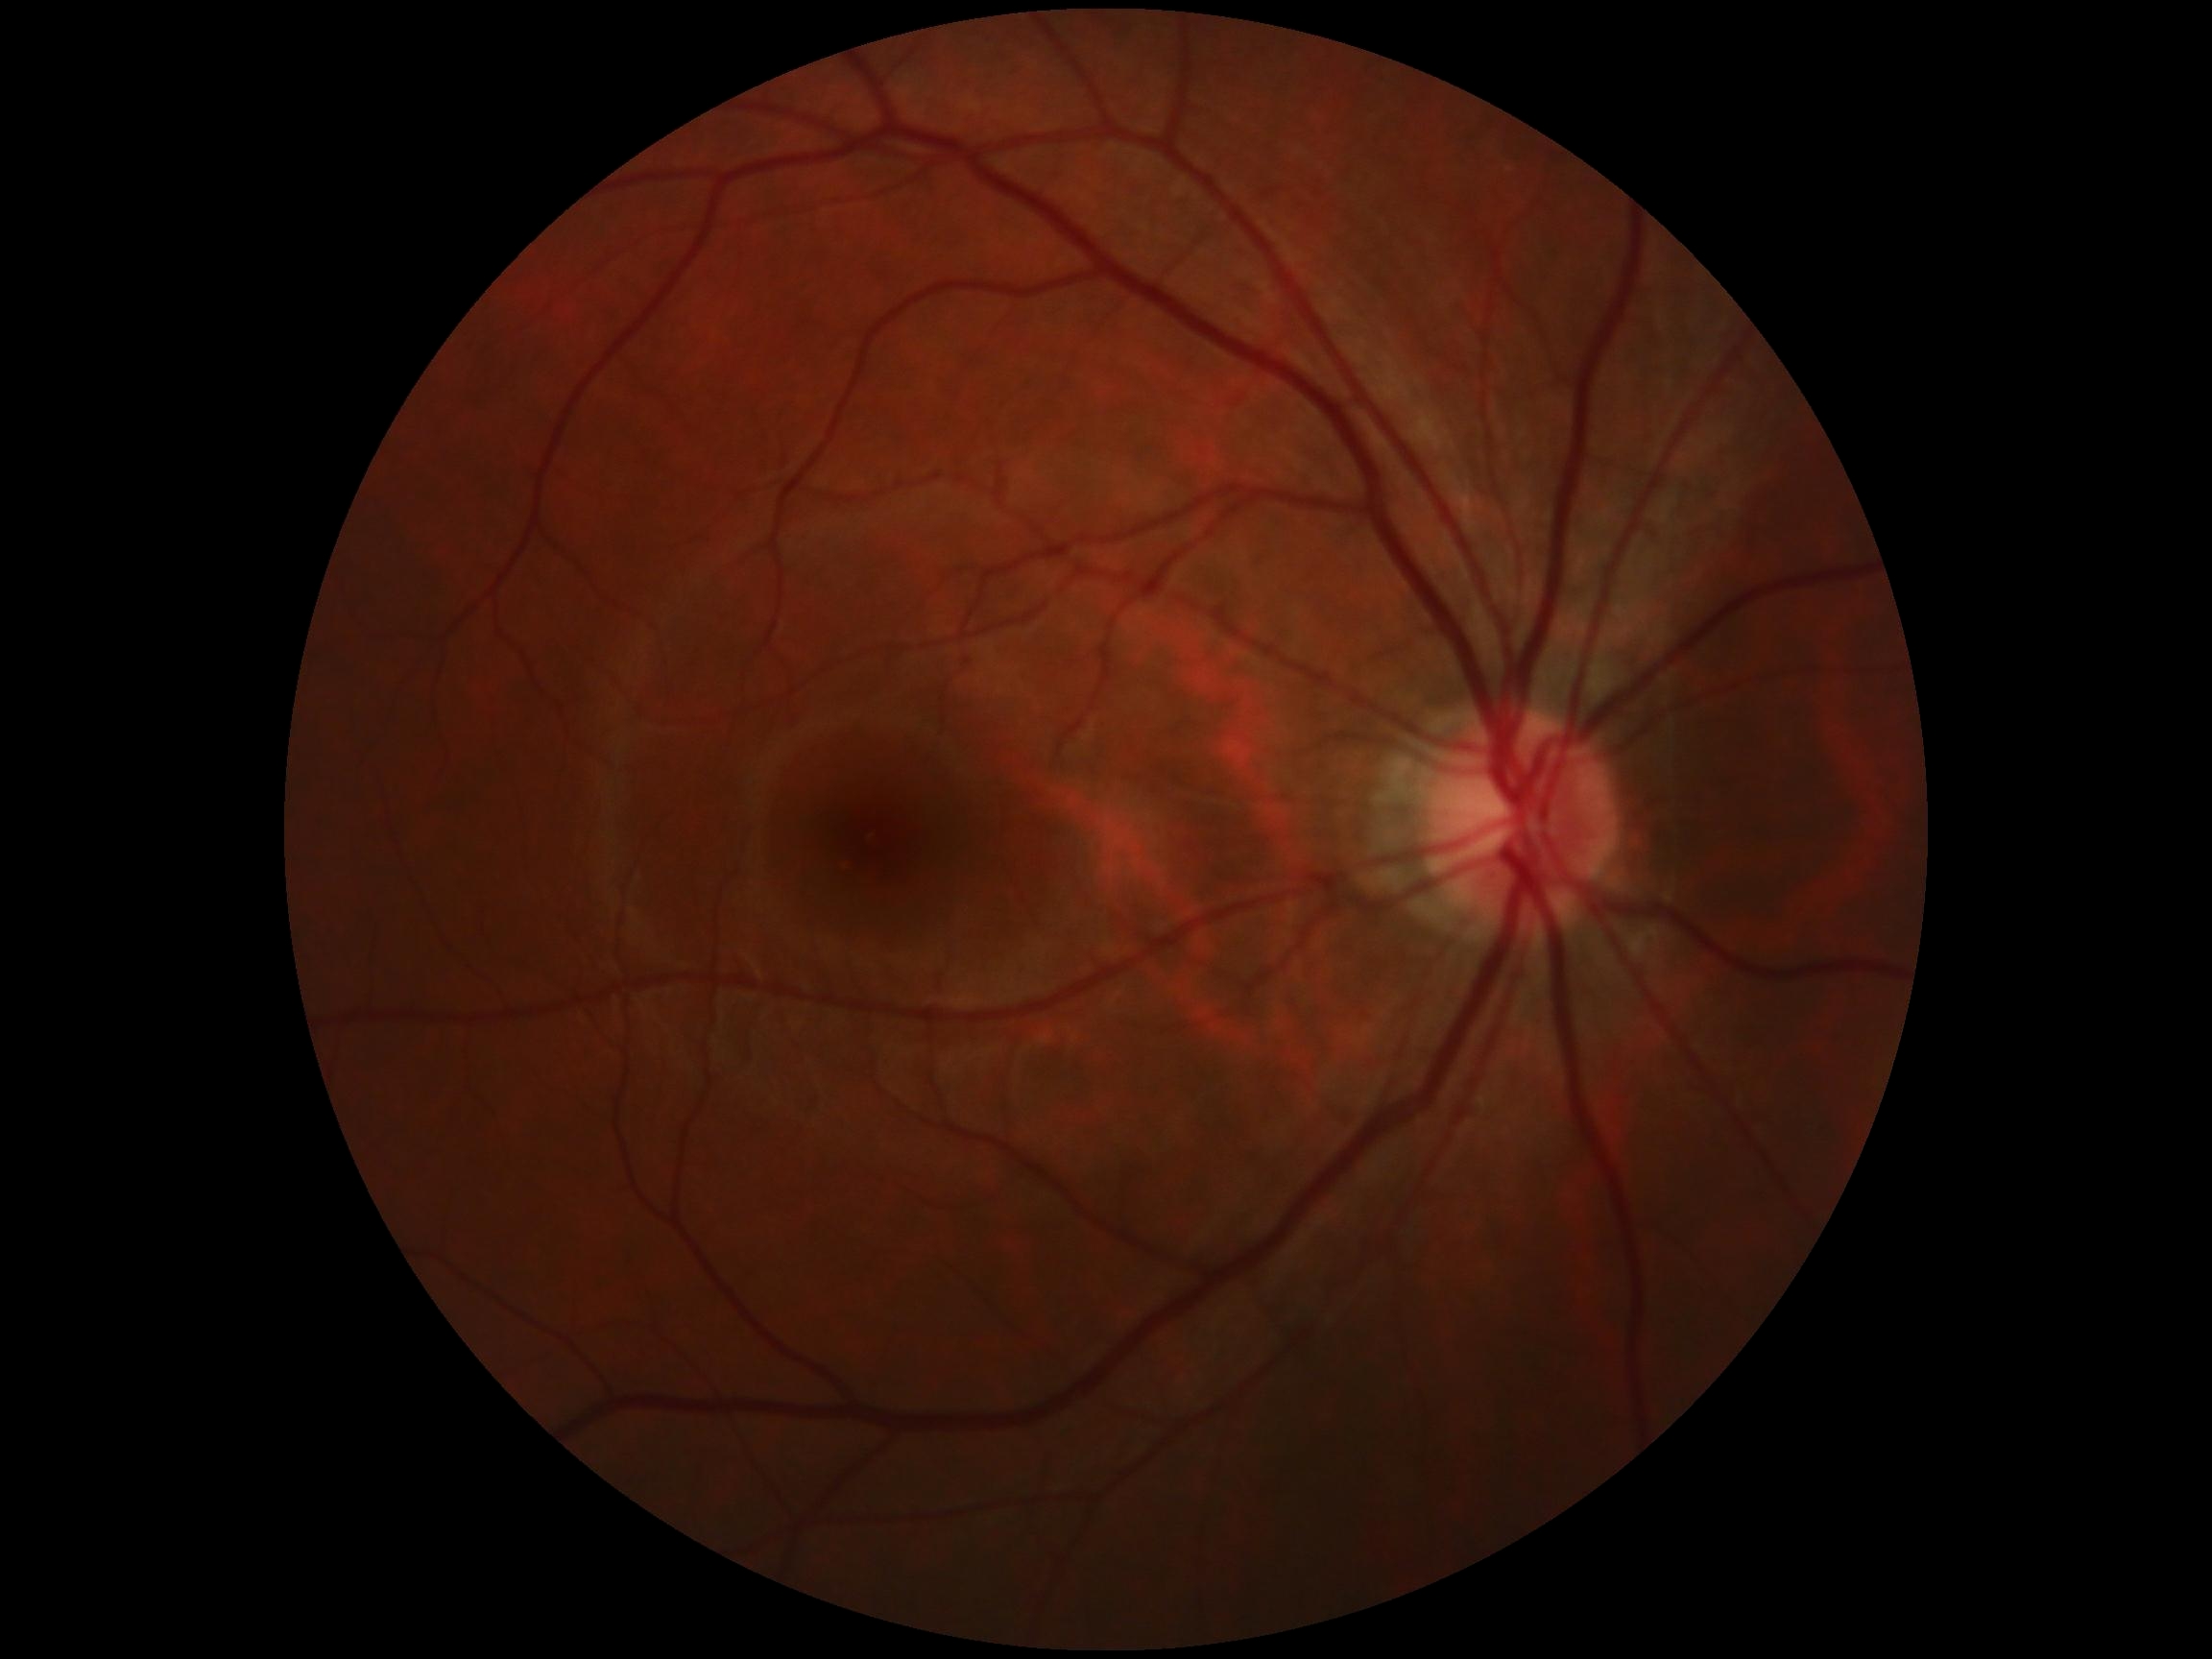

{
  "dr_grade": "0"
}